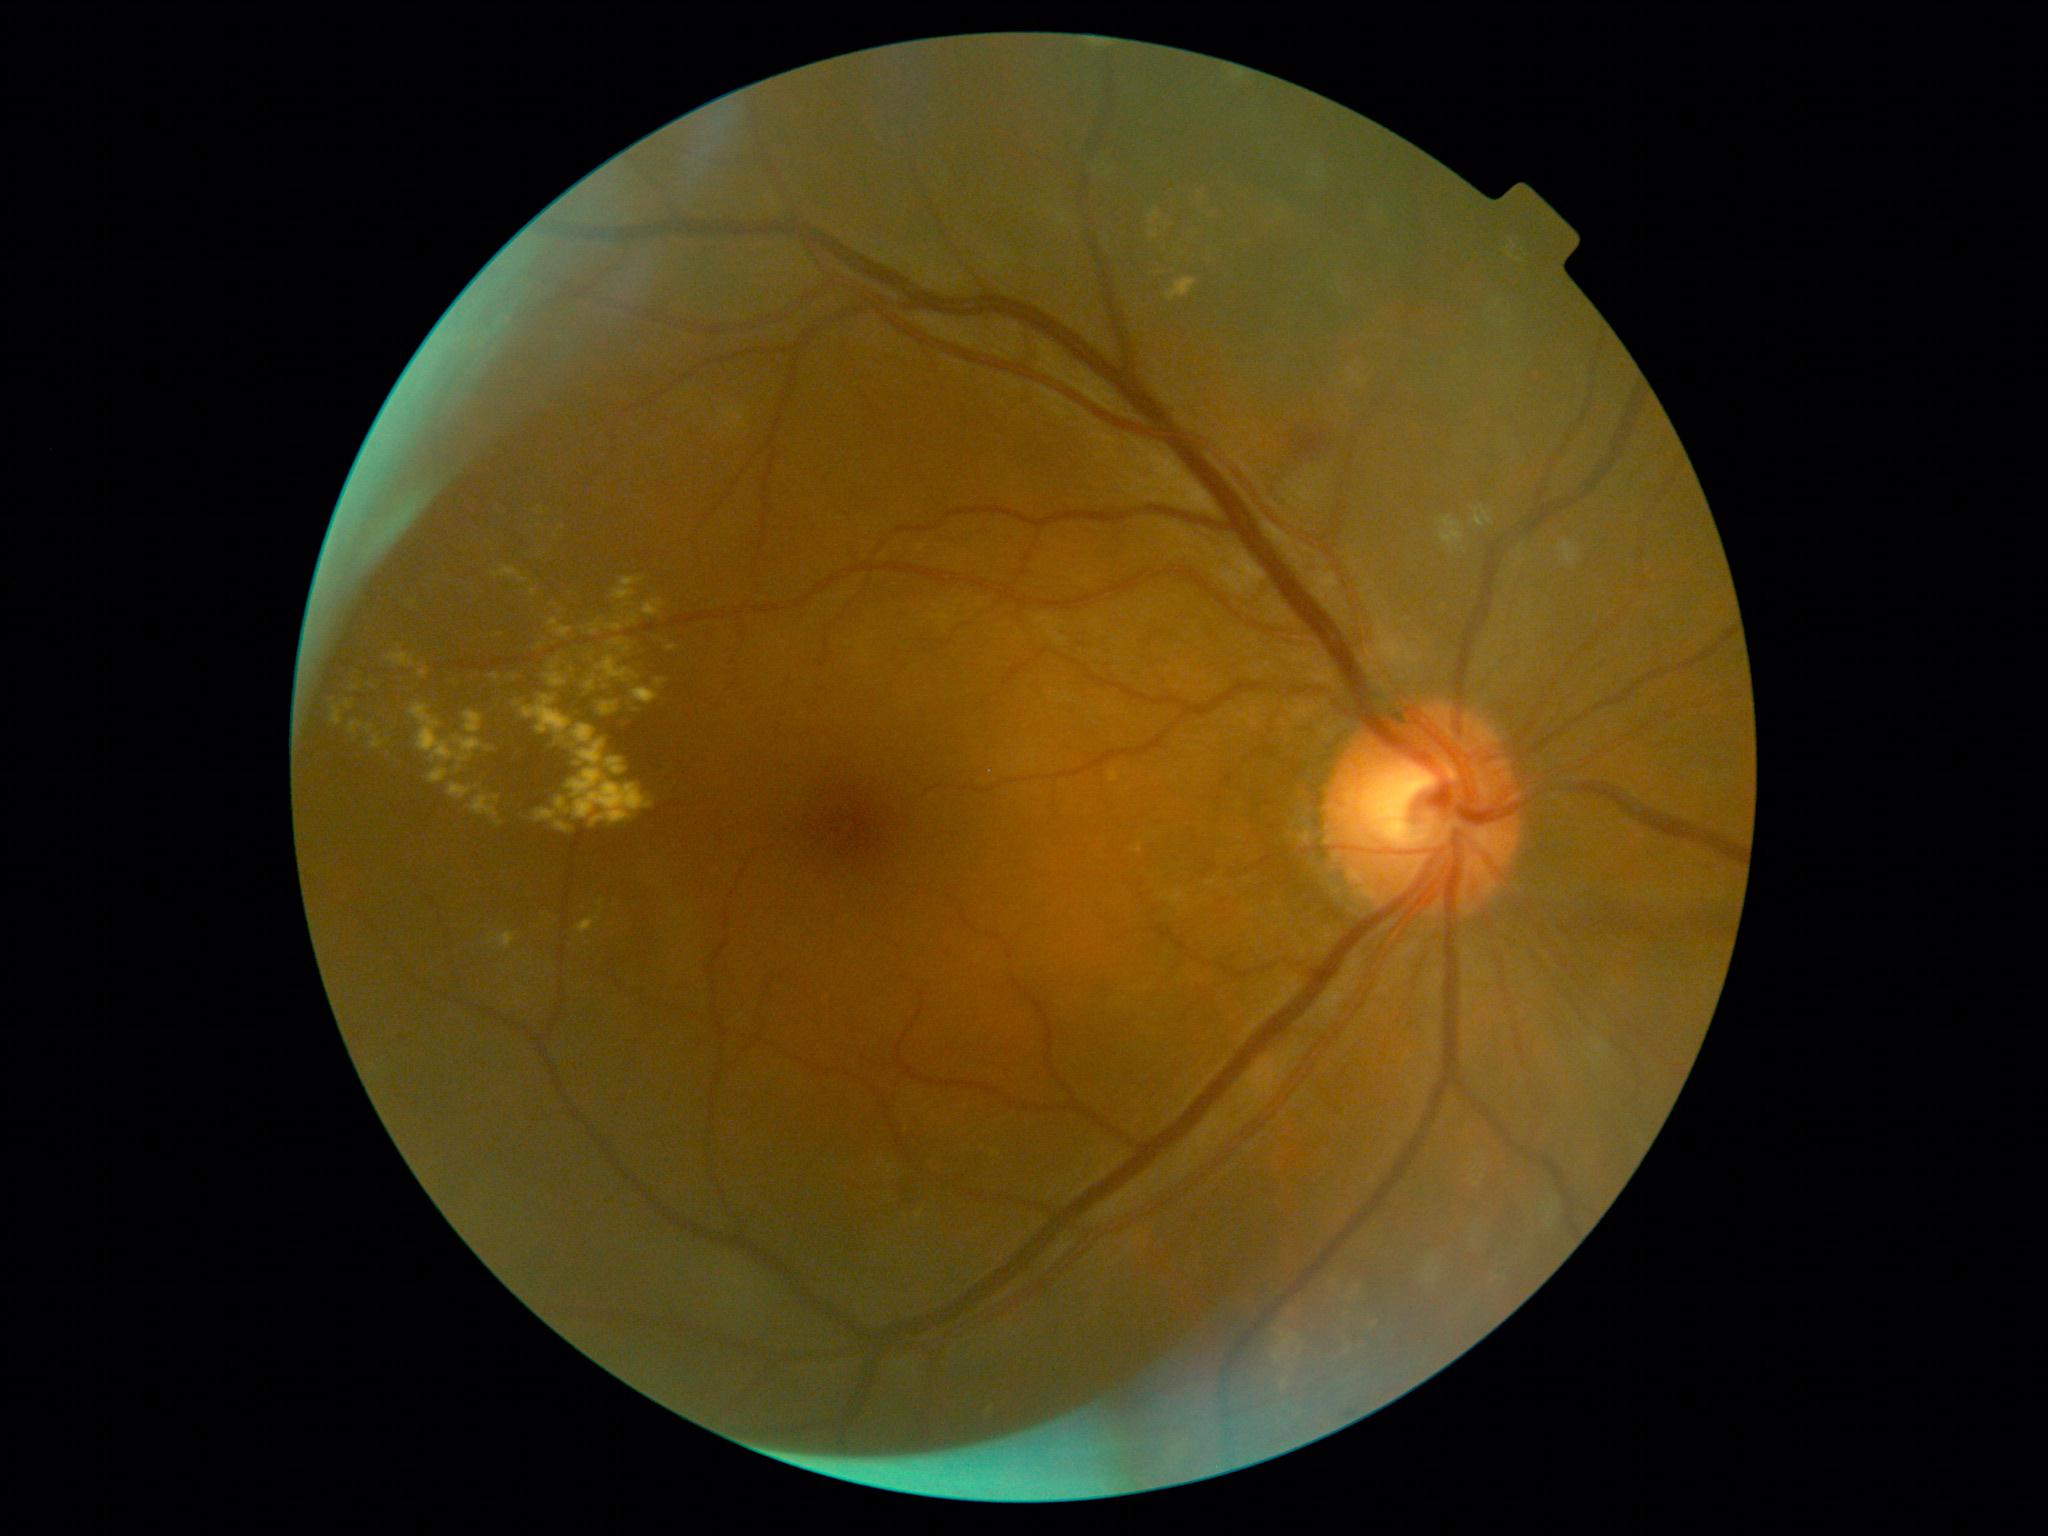

<lesions partial="true">
  <dr_grade>2</dr_grade>
  <ma />
  <ex partial="true">(489,673,501,682); (533,768,654,828); (578,739,606,767); (546,665,568,688); (596,899,605,907); (448,782,474,800); (585,676,596,692); (598,701,619,716); (492,566,529,583); (447,673,461,689); (1282,1378,1289,1391); (601,729,612,741); (469,794,504,827); (549,592,566,616)</ex>
  <ex_small_centers>x=627, y=649; x=564, y=528; x=579, y=765; x=459, y=769</ex_small_centers>
  <he>(897,1166,918,1205); (1289,422,1336,464)</he>
  <se />
</lesions>